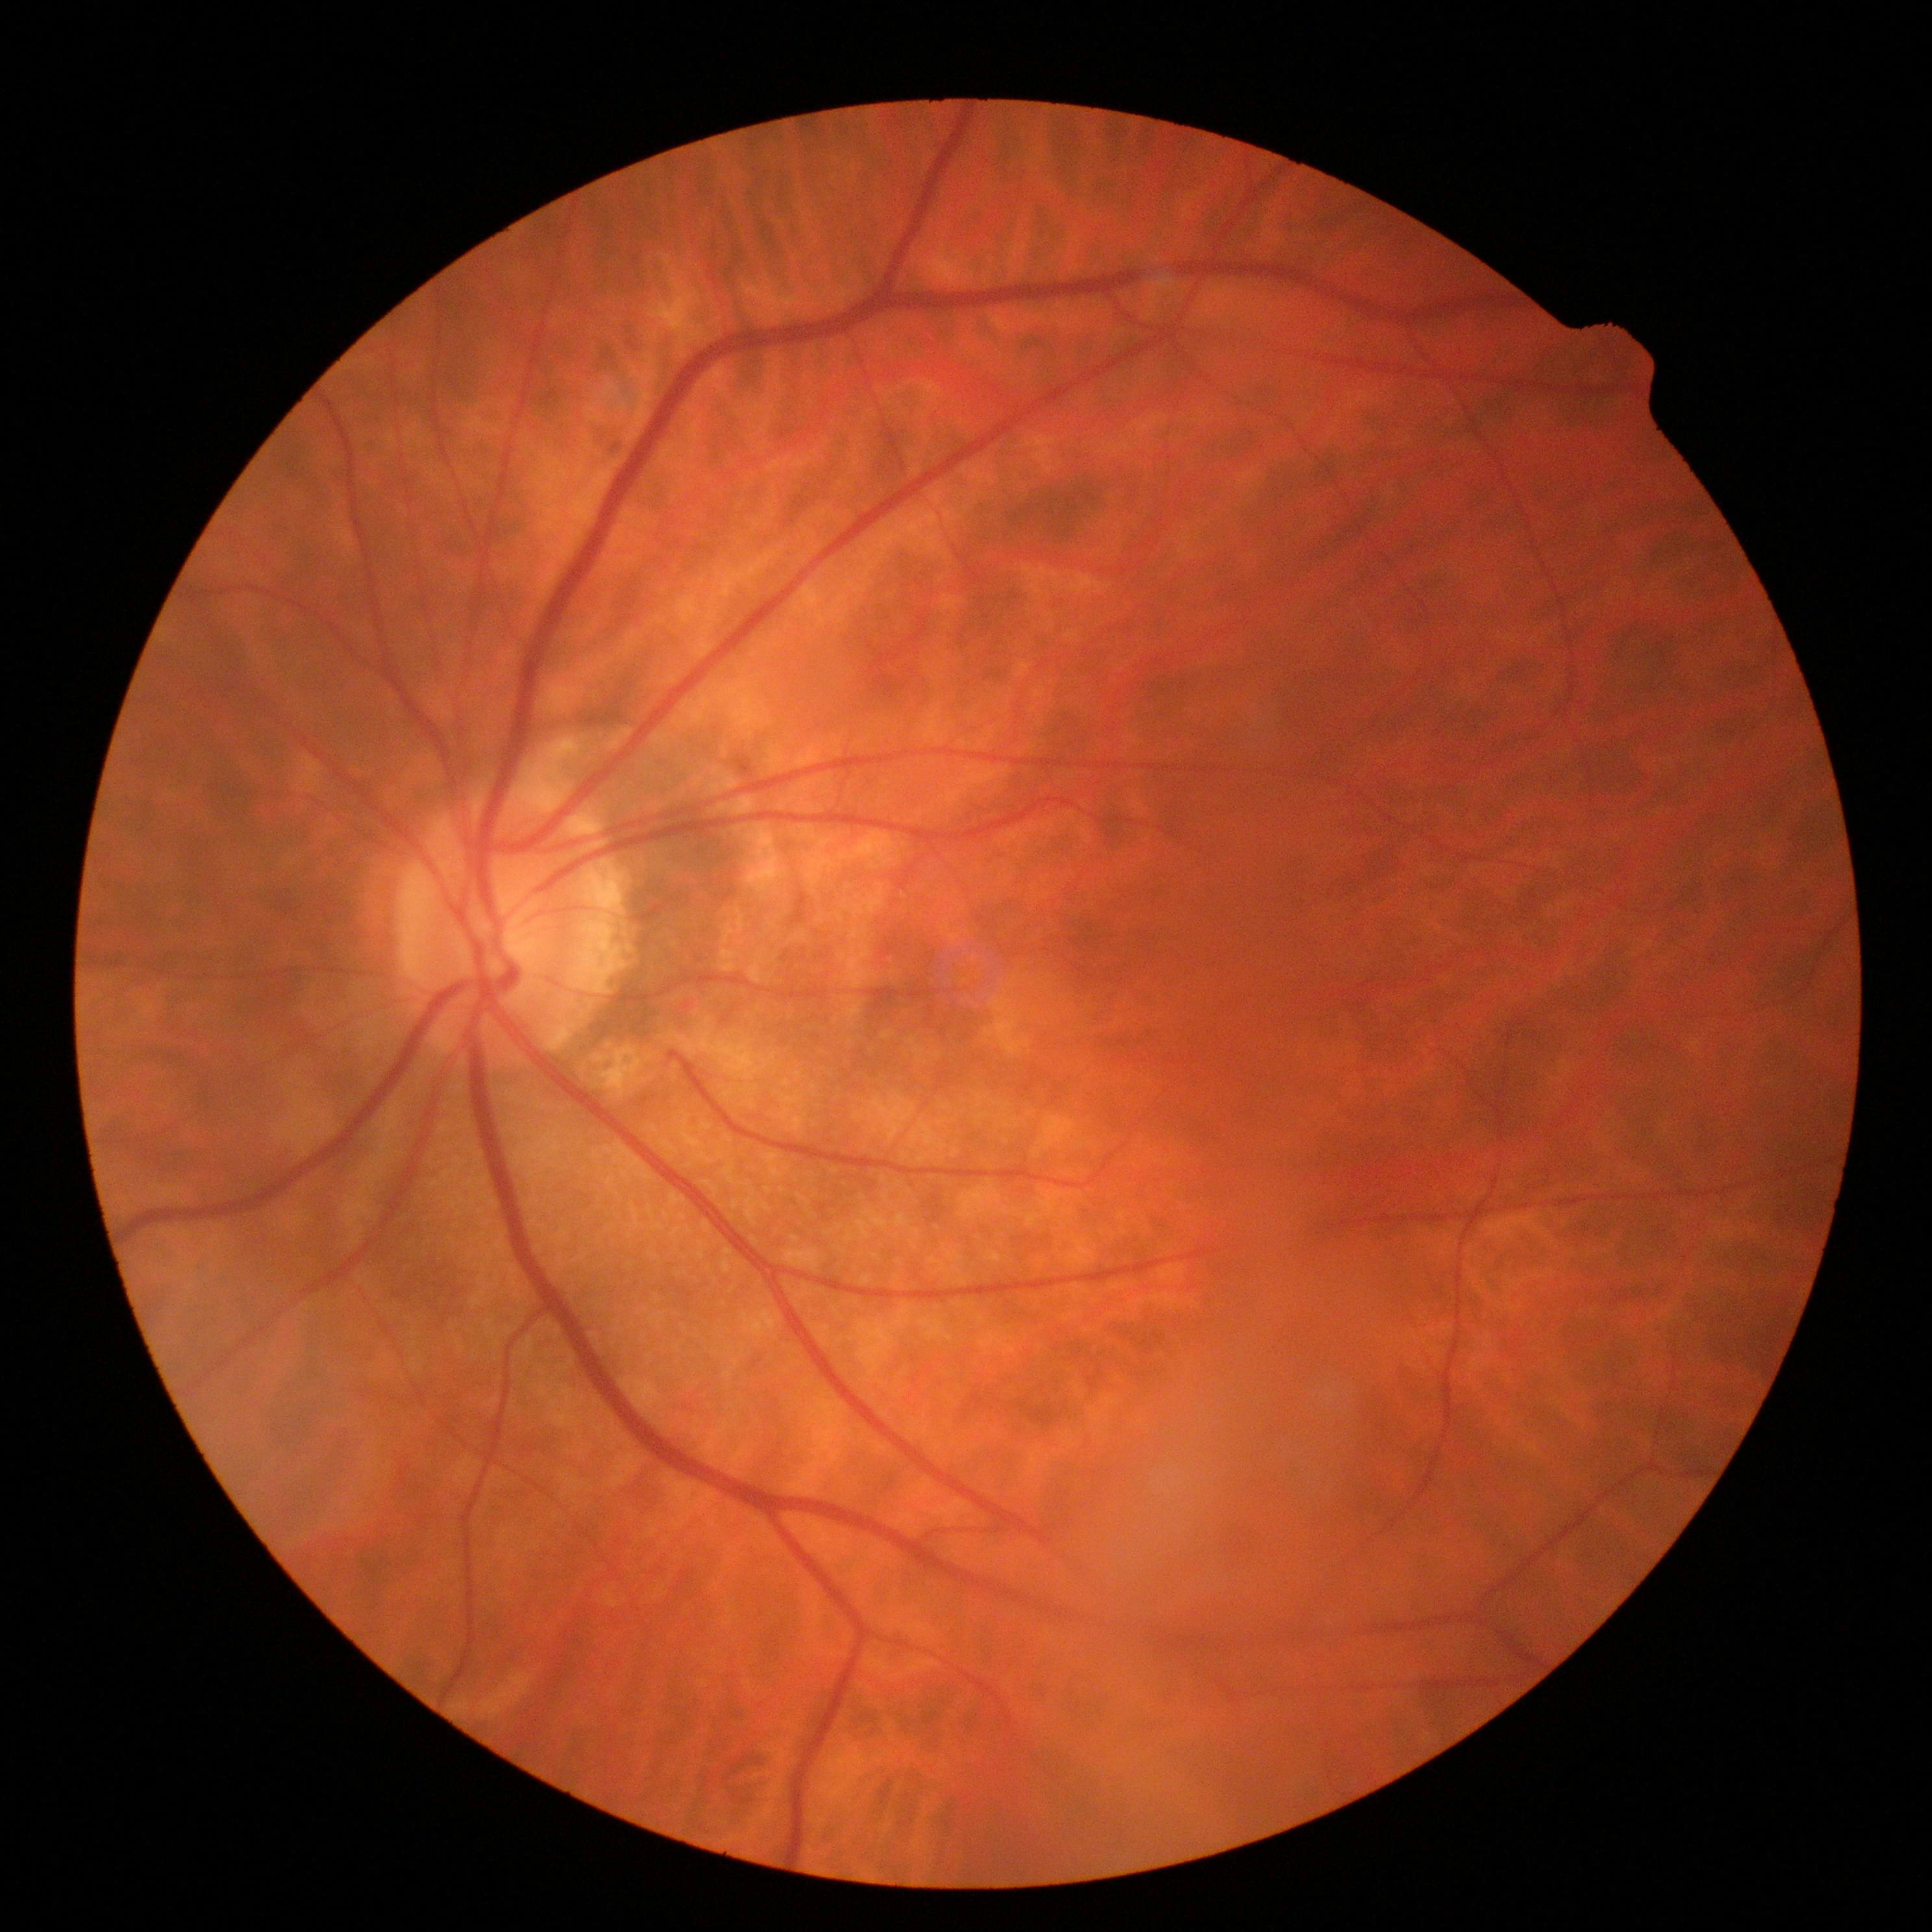

Diabetic retinopathy severity: no apparent diabetic retinopathy (grade 0) — no visible signs of diabetic retinopathy.